Pachymetry 506 µm; axial length (AL) 24.5 mm; refractive error: +1.75 -2 × 85° — 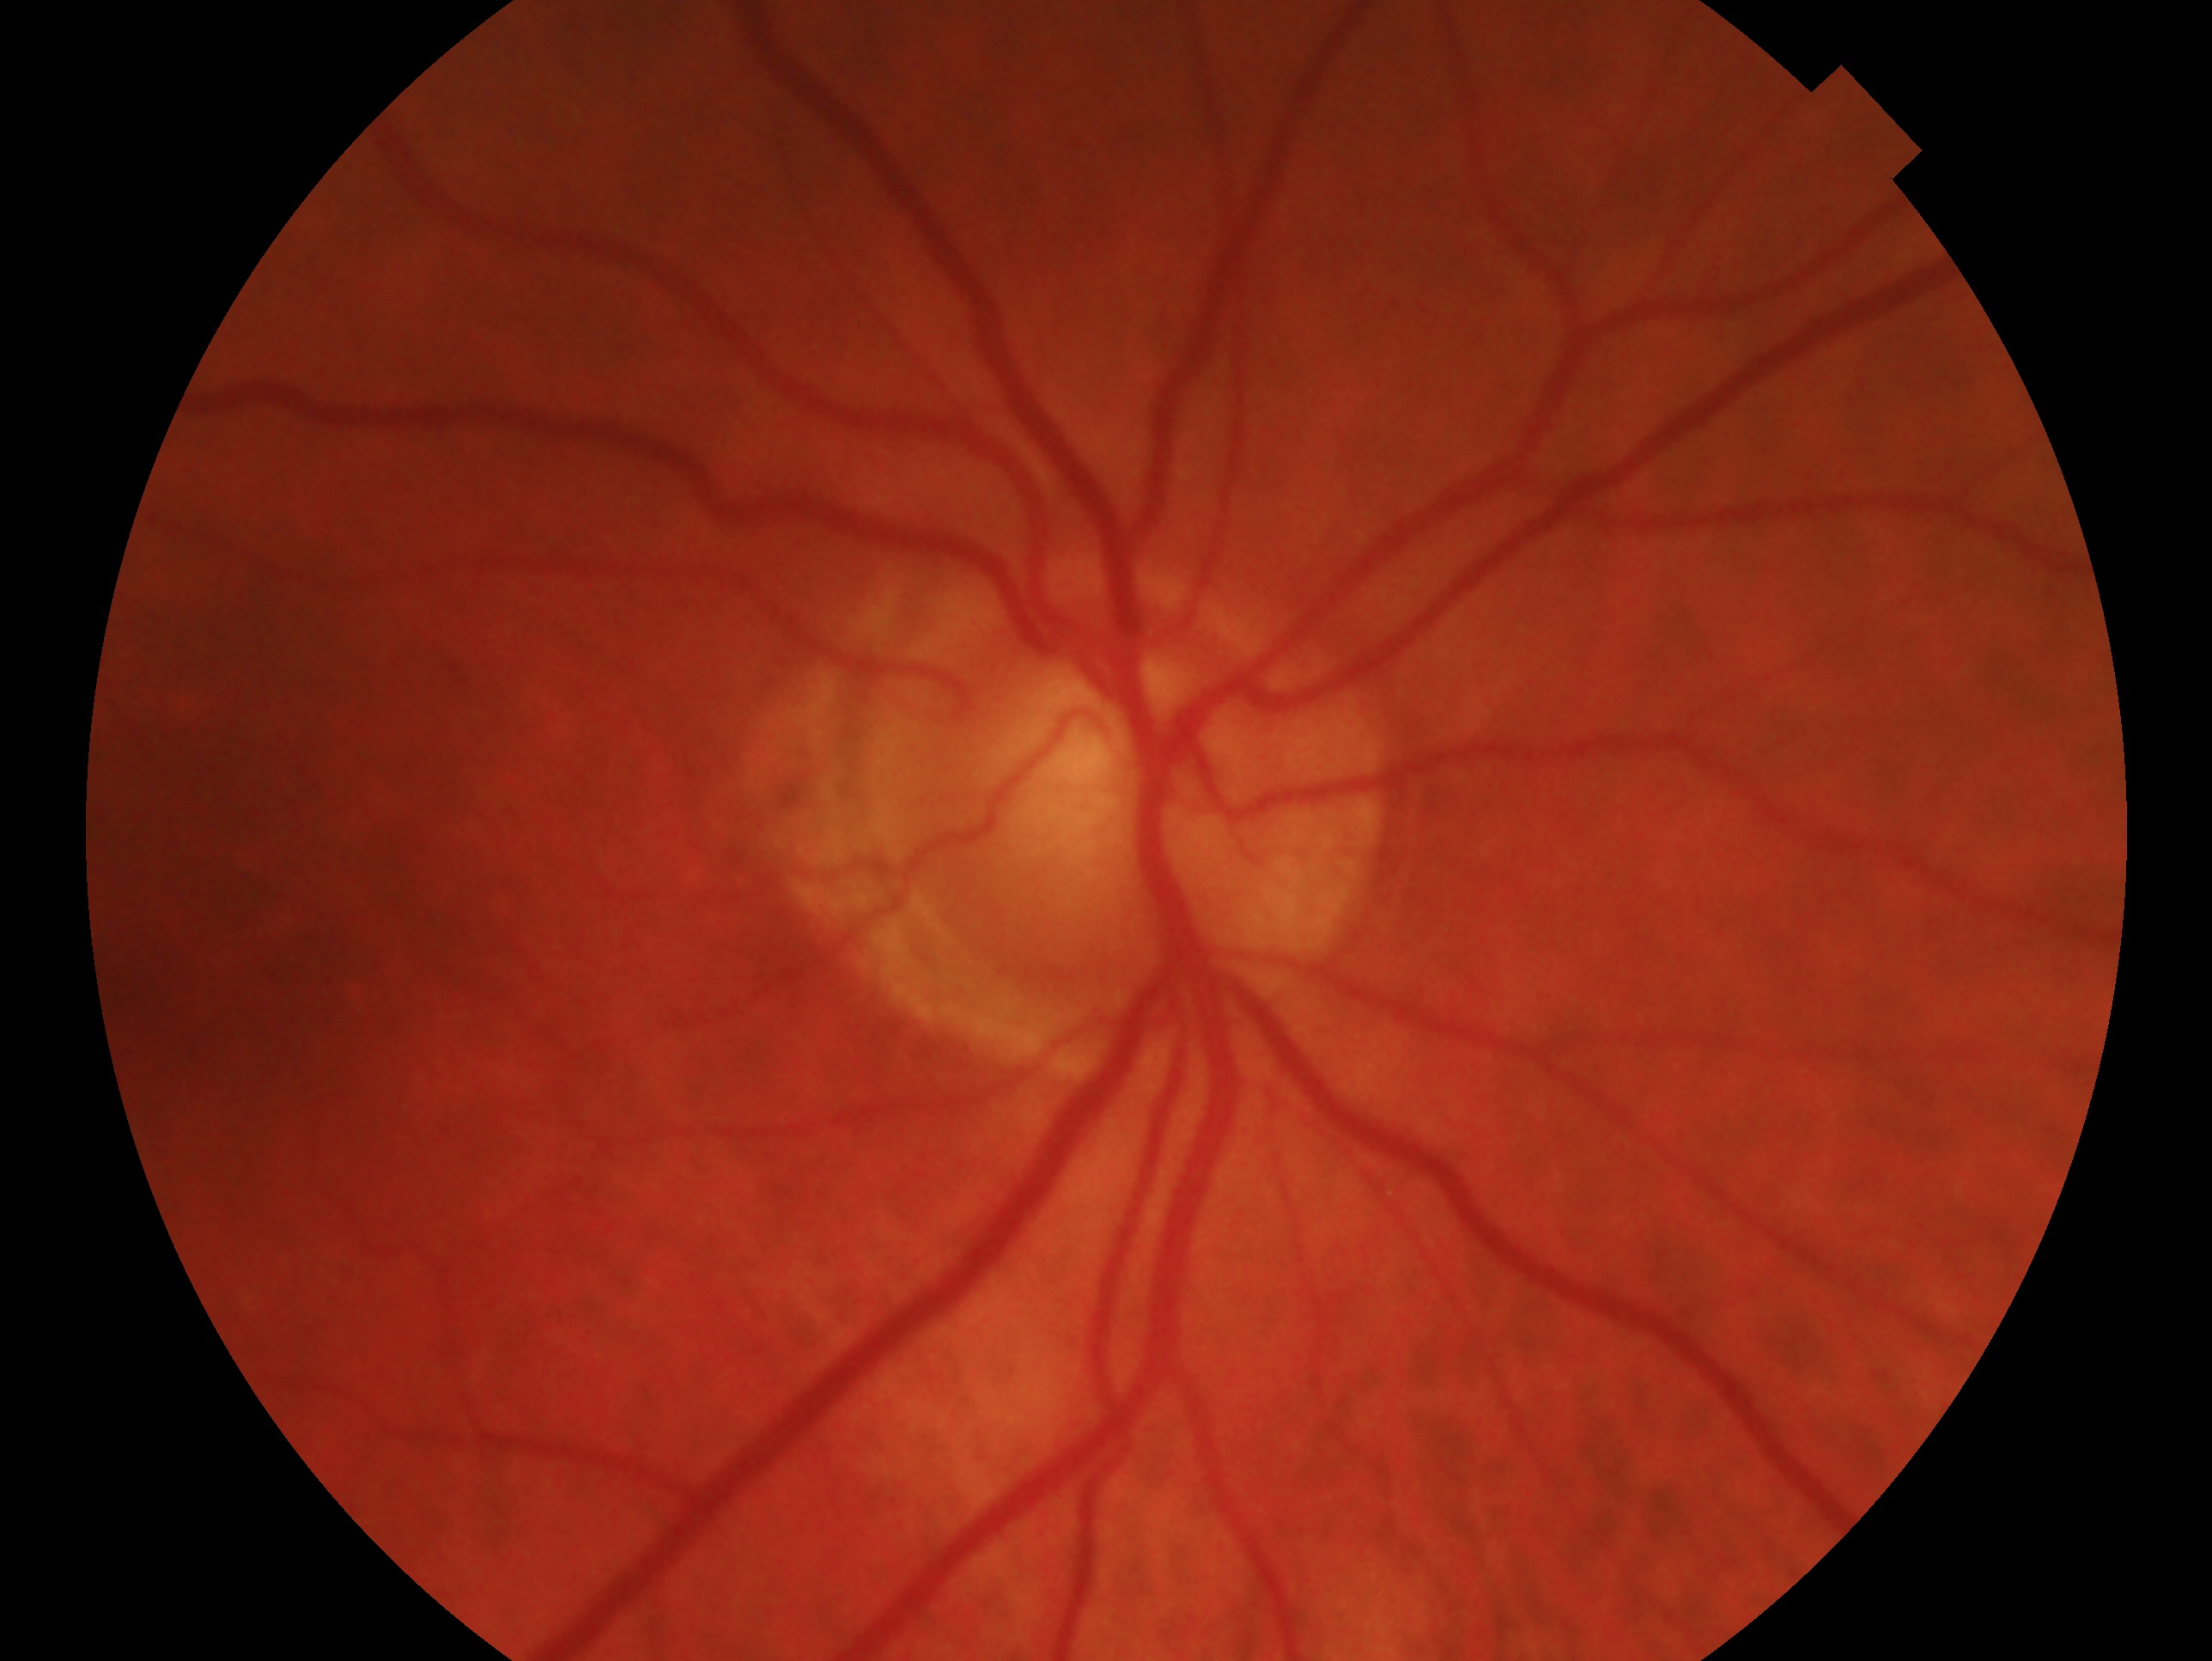
Impression: no glaucoma — no clinical evidence of glaucoma in this eye. This is the OD.